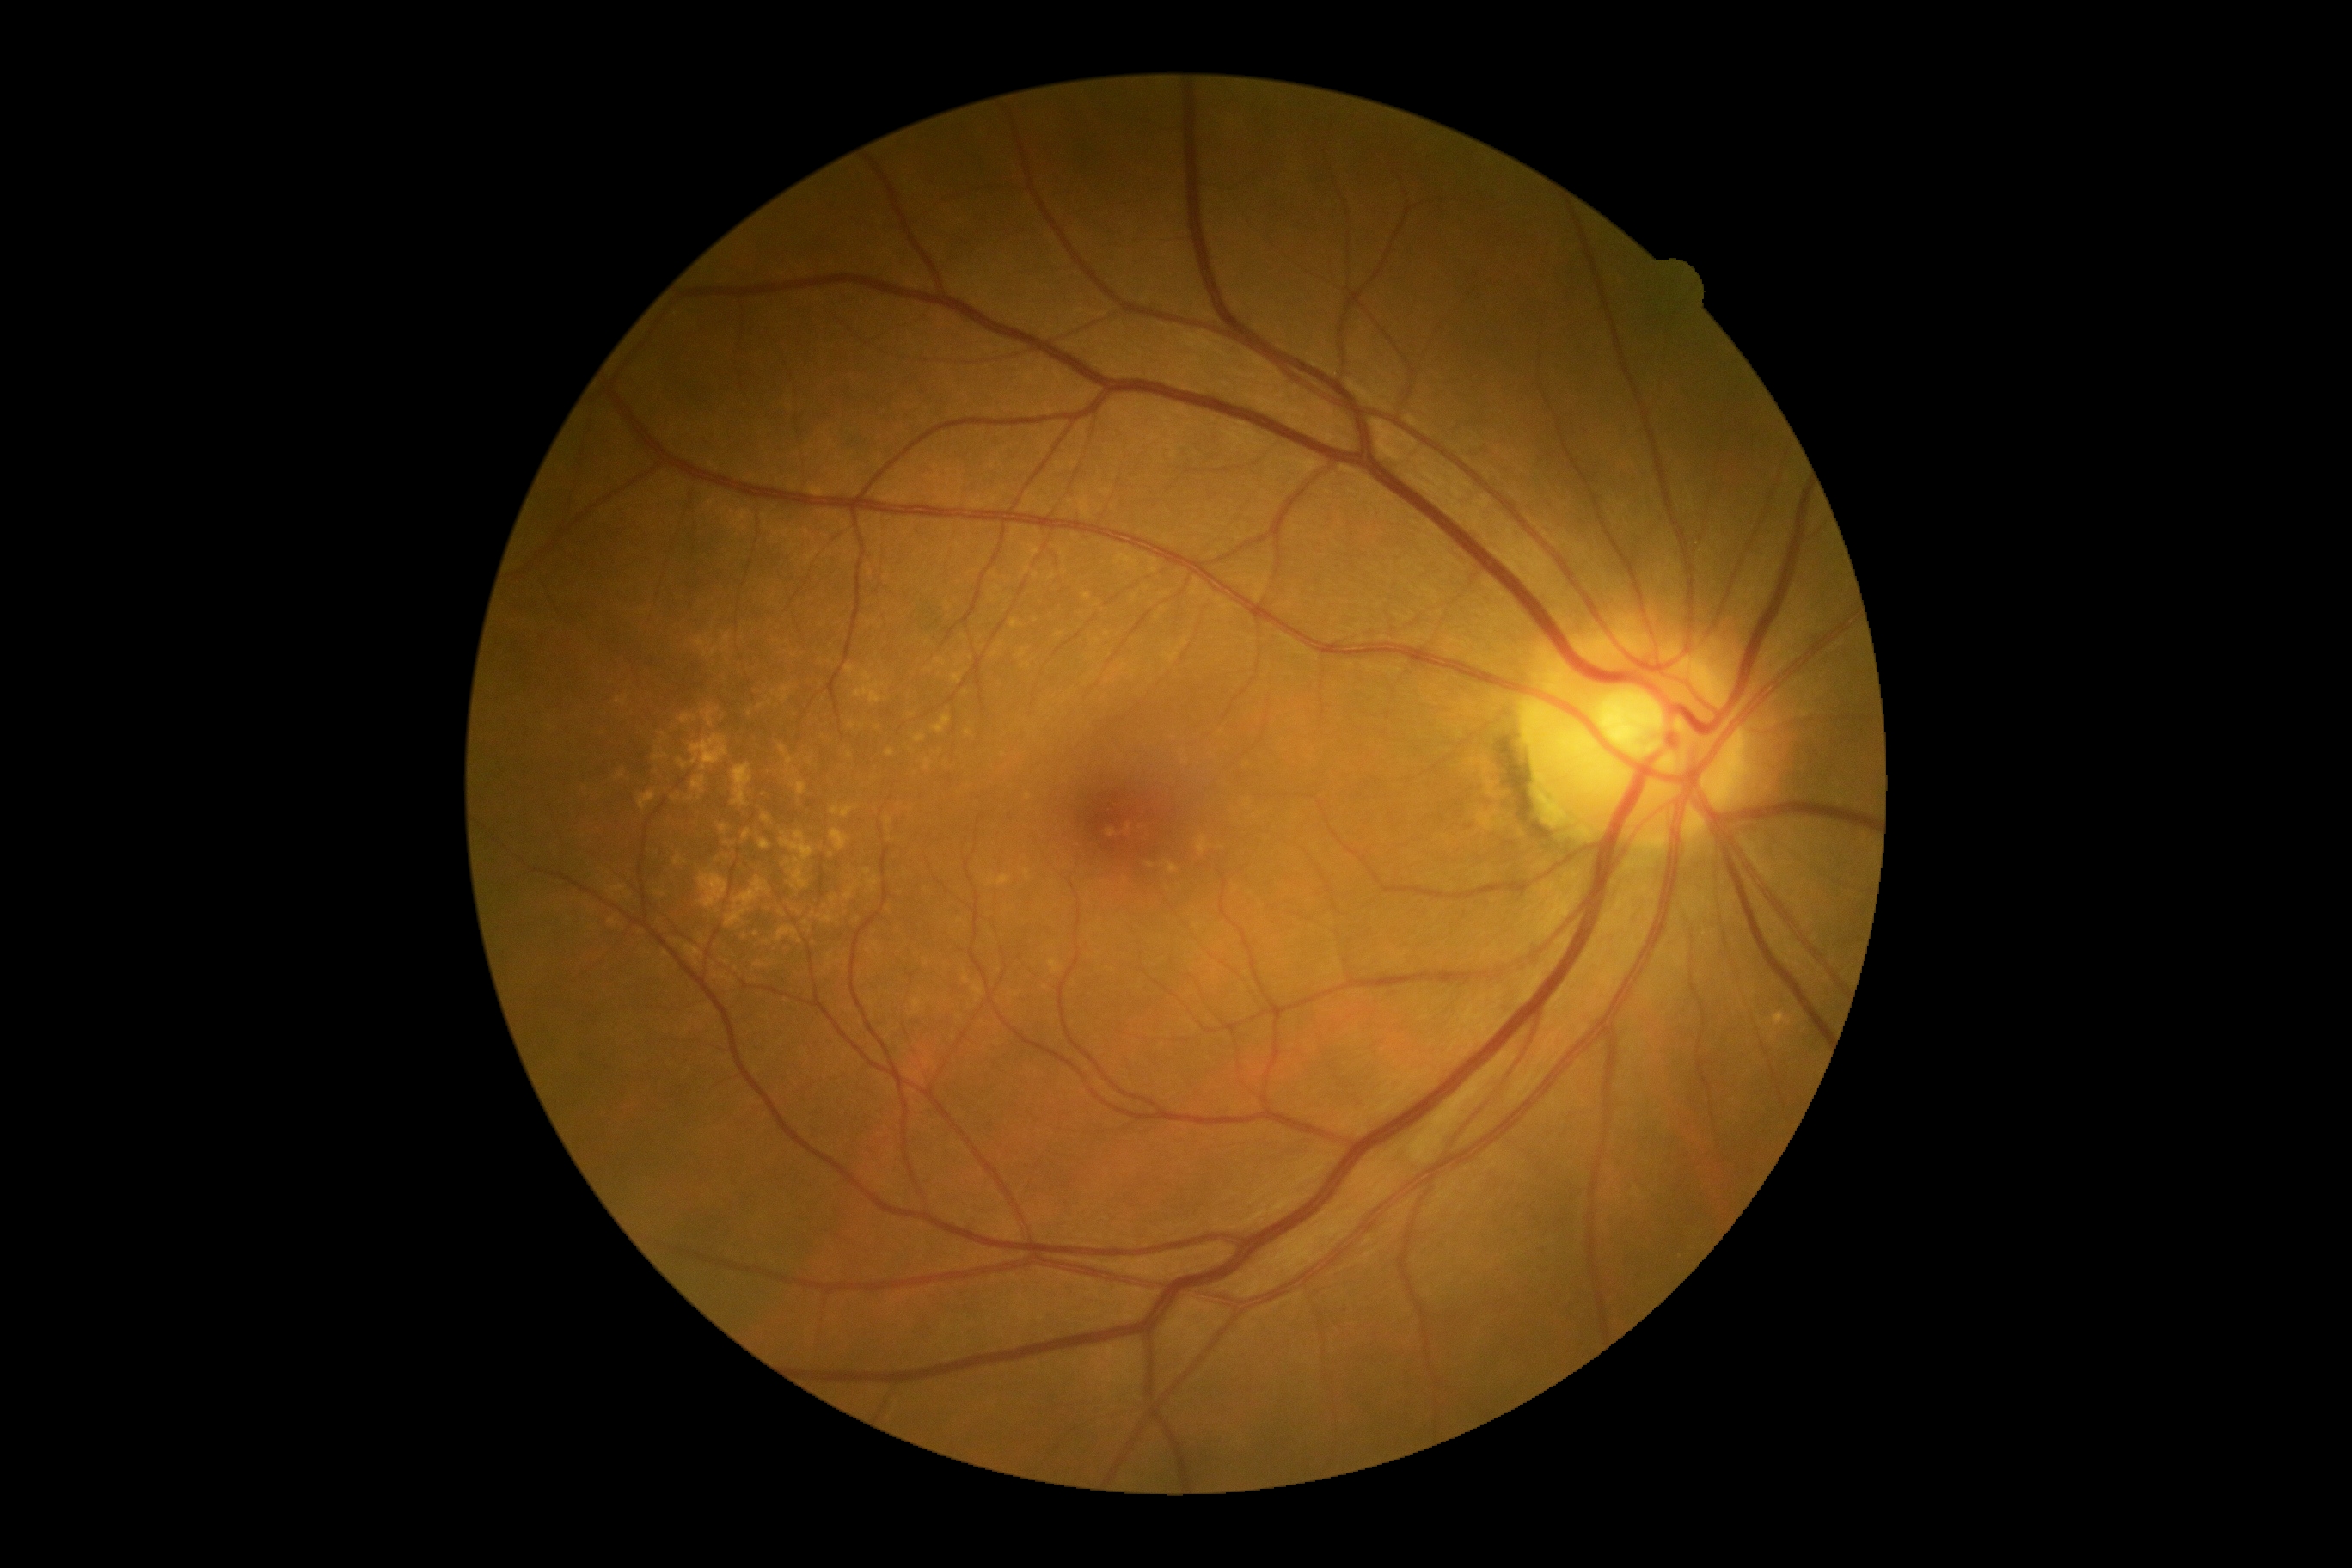
DR = 0/4.